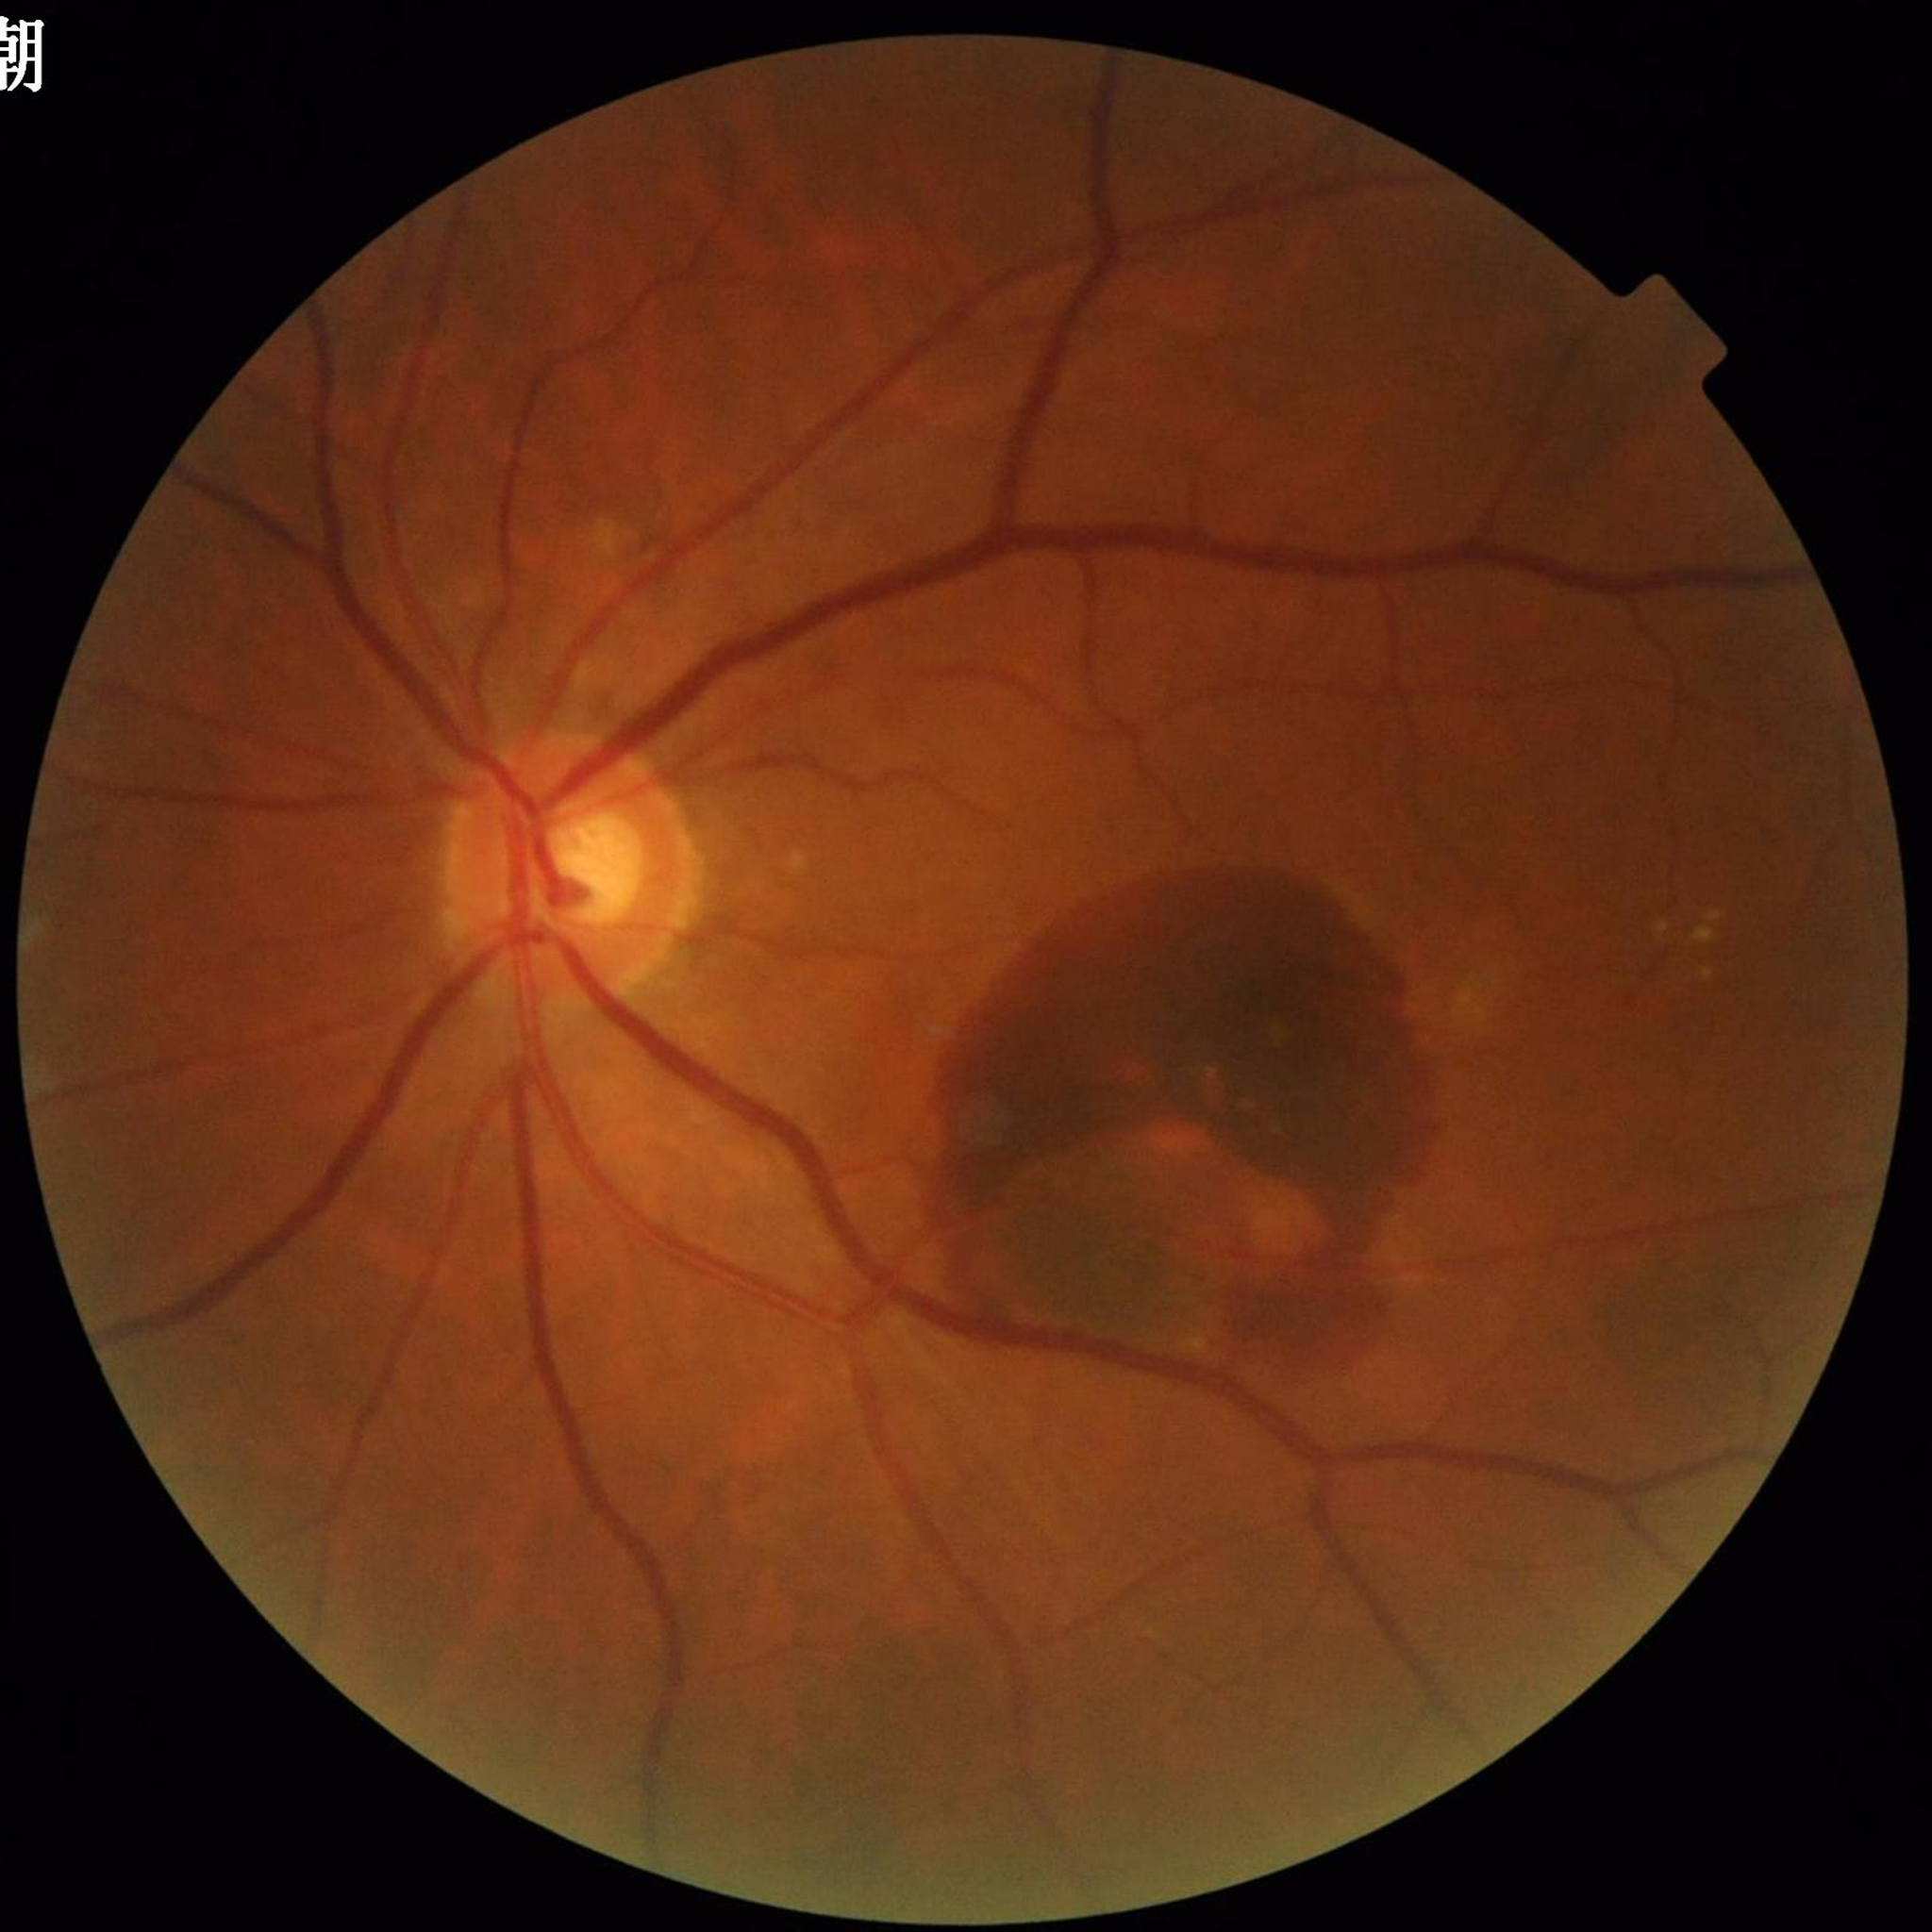
Retinal fundus photograph from a patient with age-related macular degeneration.